Wide-field fundus image from infant ROP screening. Acquired on the Phoenix ICON. Image size 1240x1240: 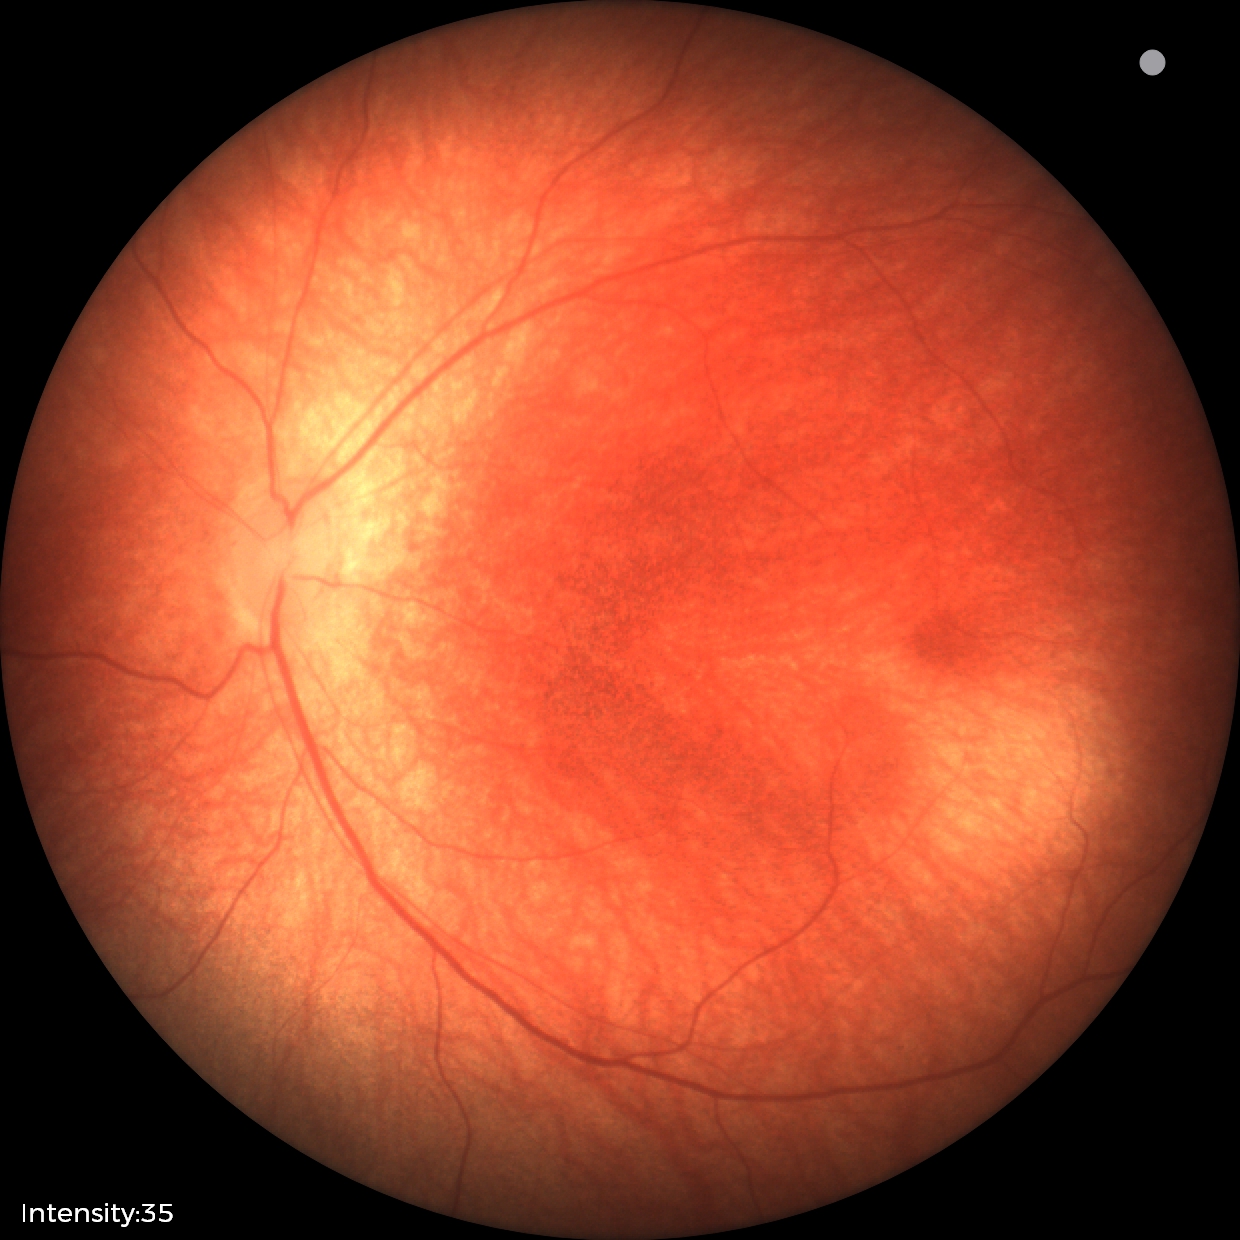
Q: What is the diagnosis from this examination?
A: physiological appearance with no retinal pathology